45° field of view. Retinal fundus photograph — 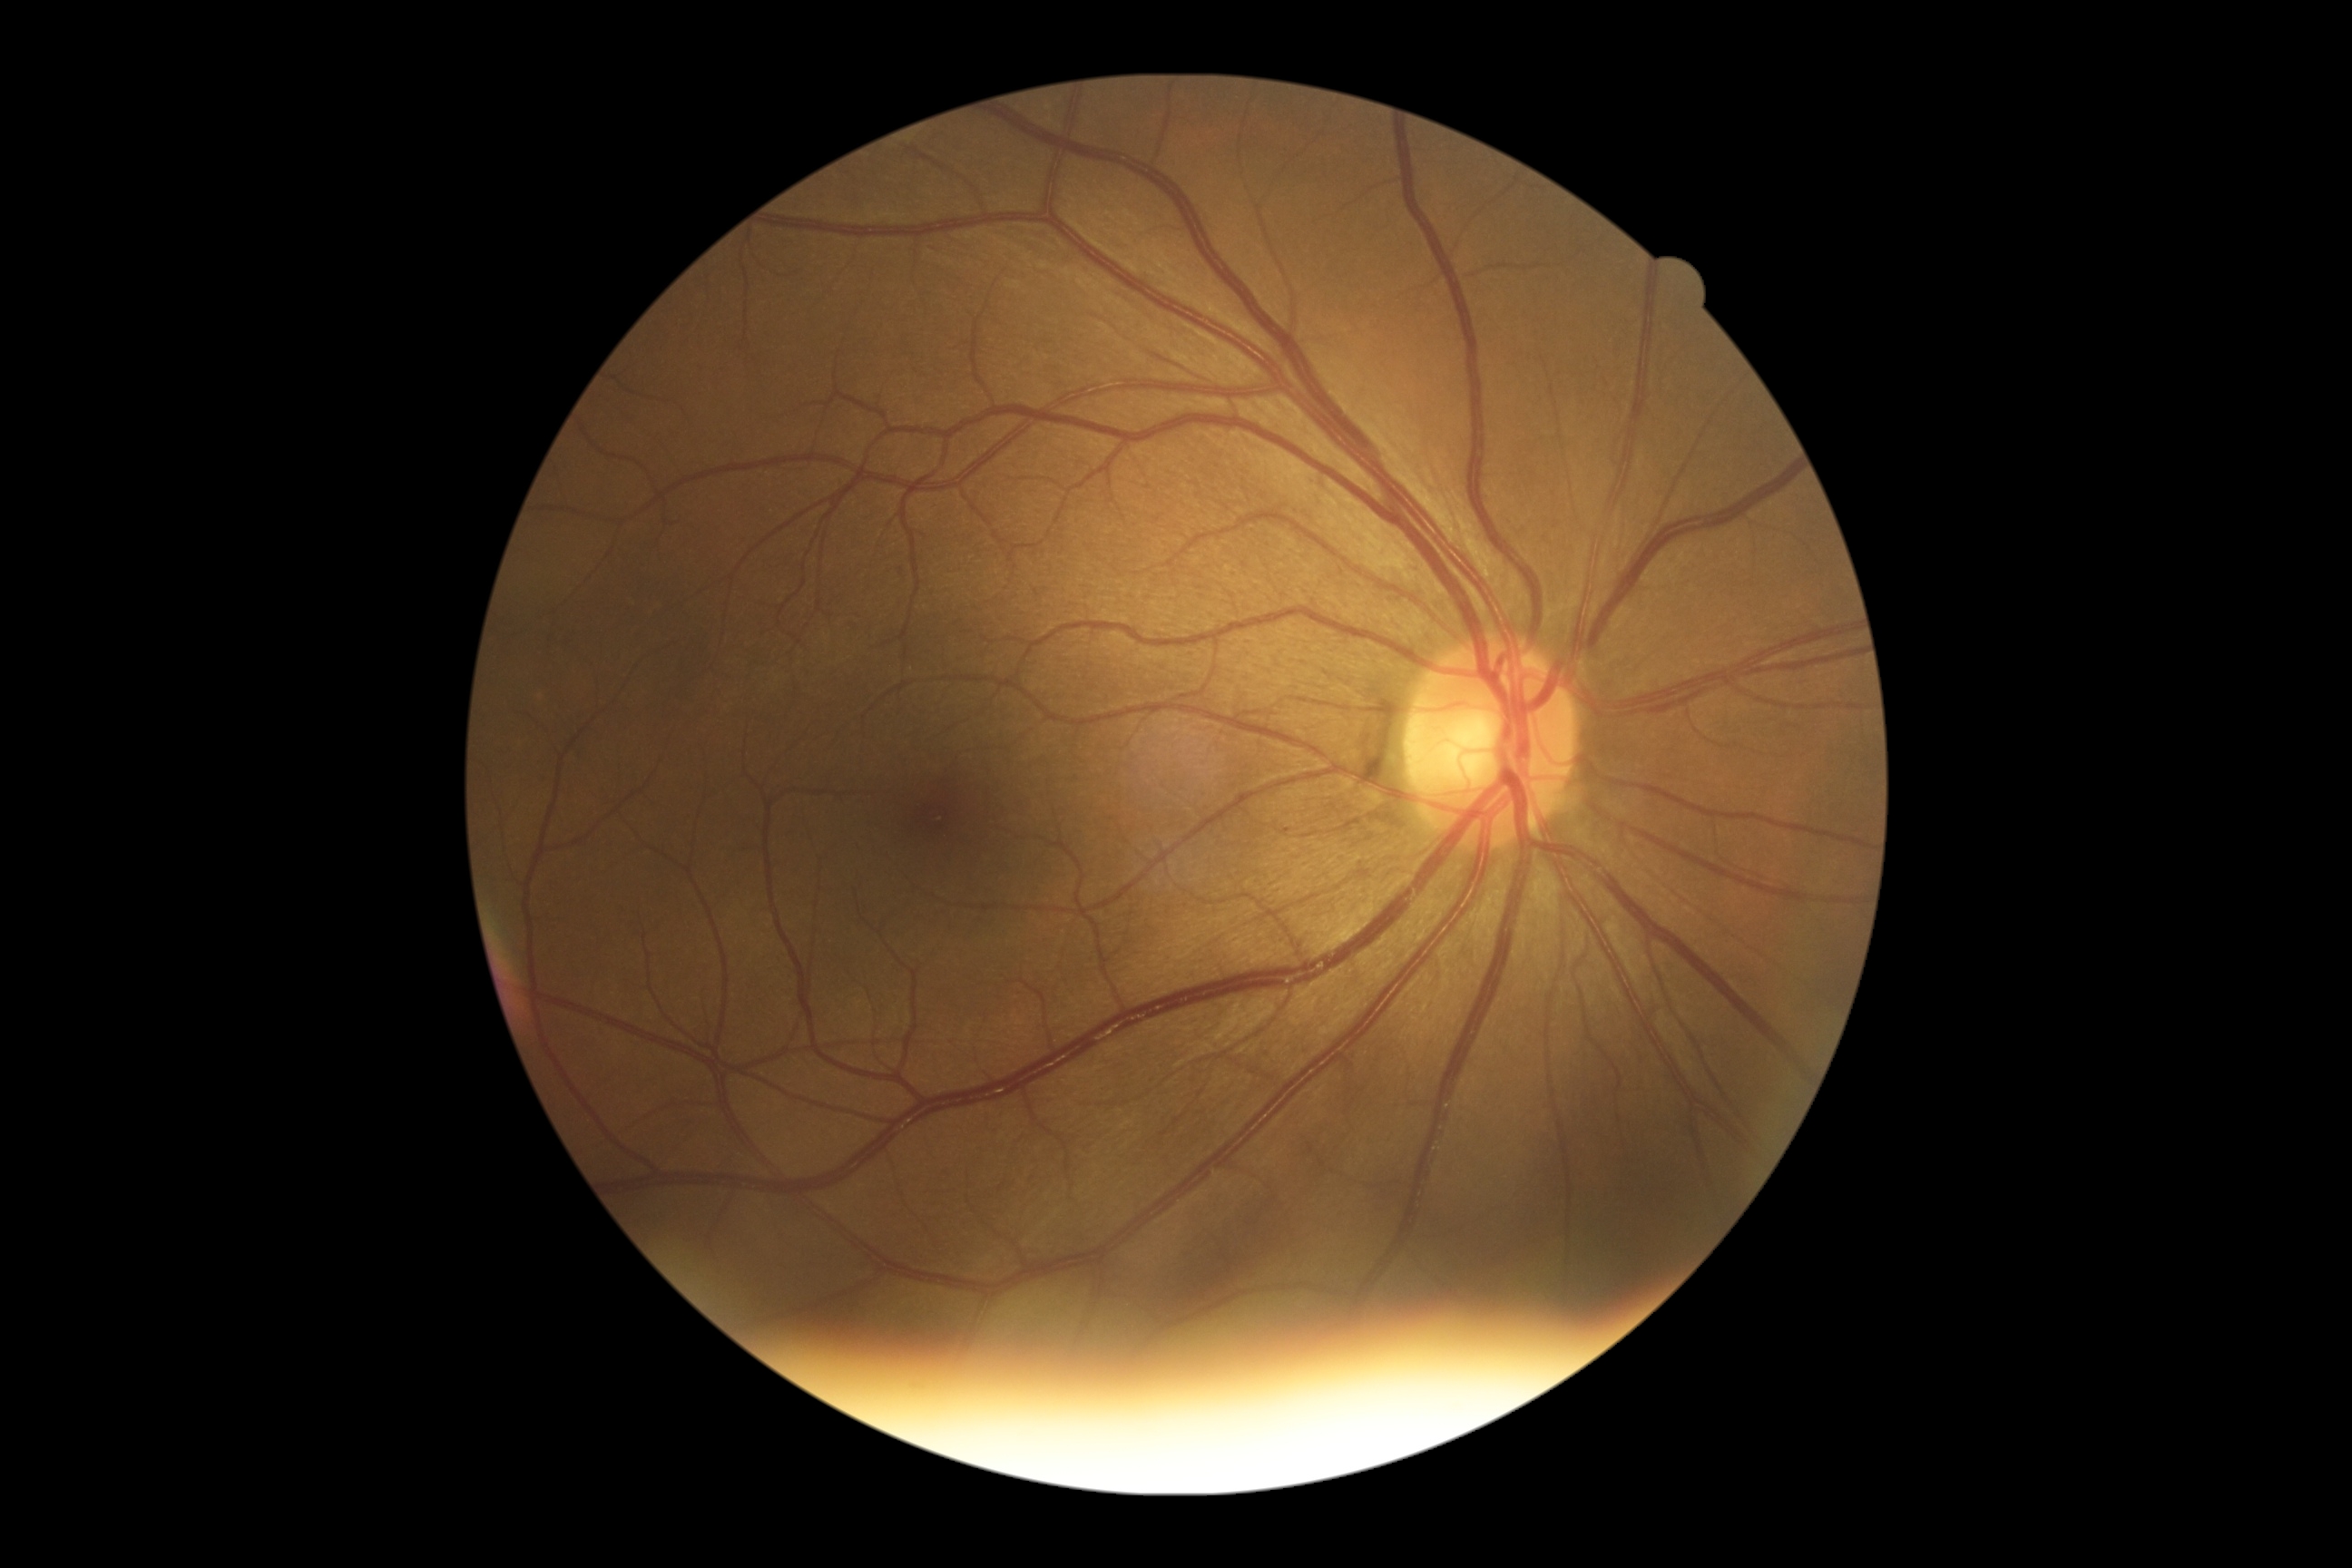

Diabetic retinopathy grade: 0 (no apparent retinopathy) — no visible signs of diabetic retinopathy.